Retinal fundus photograph — 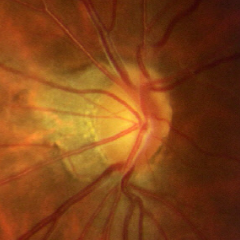
Q: Does this eye have glaucoma?
A: Yes — early glaucoma. Diagnostic criteria: glaucomatous retinal nerve fiber layer defects on red-free fundus photography without visual field defects.